Retinal fundus photograph · 2212x1659 · FOV: 45 degrees — 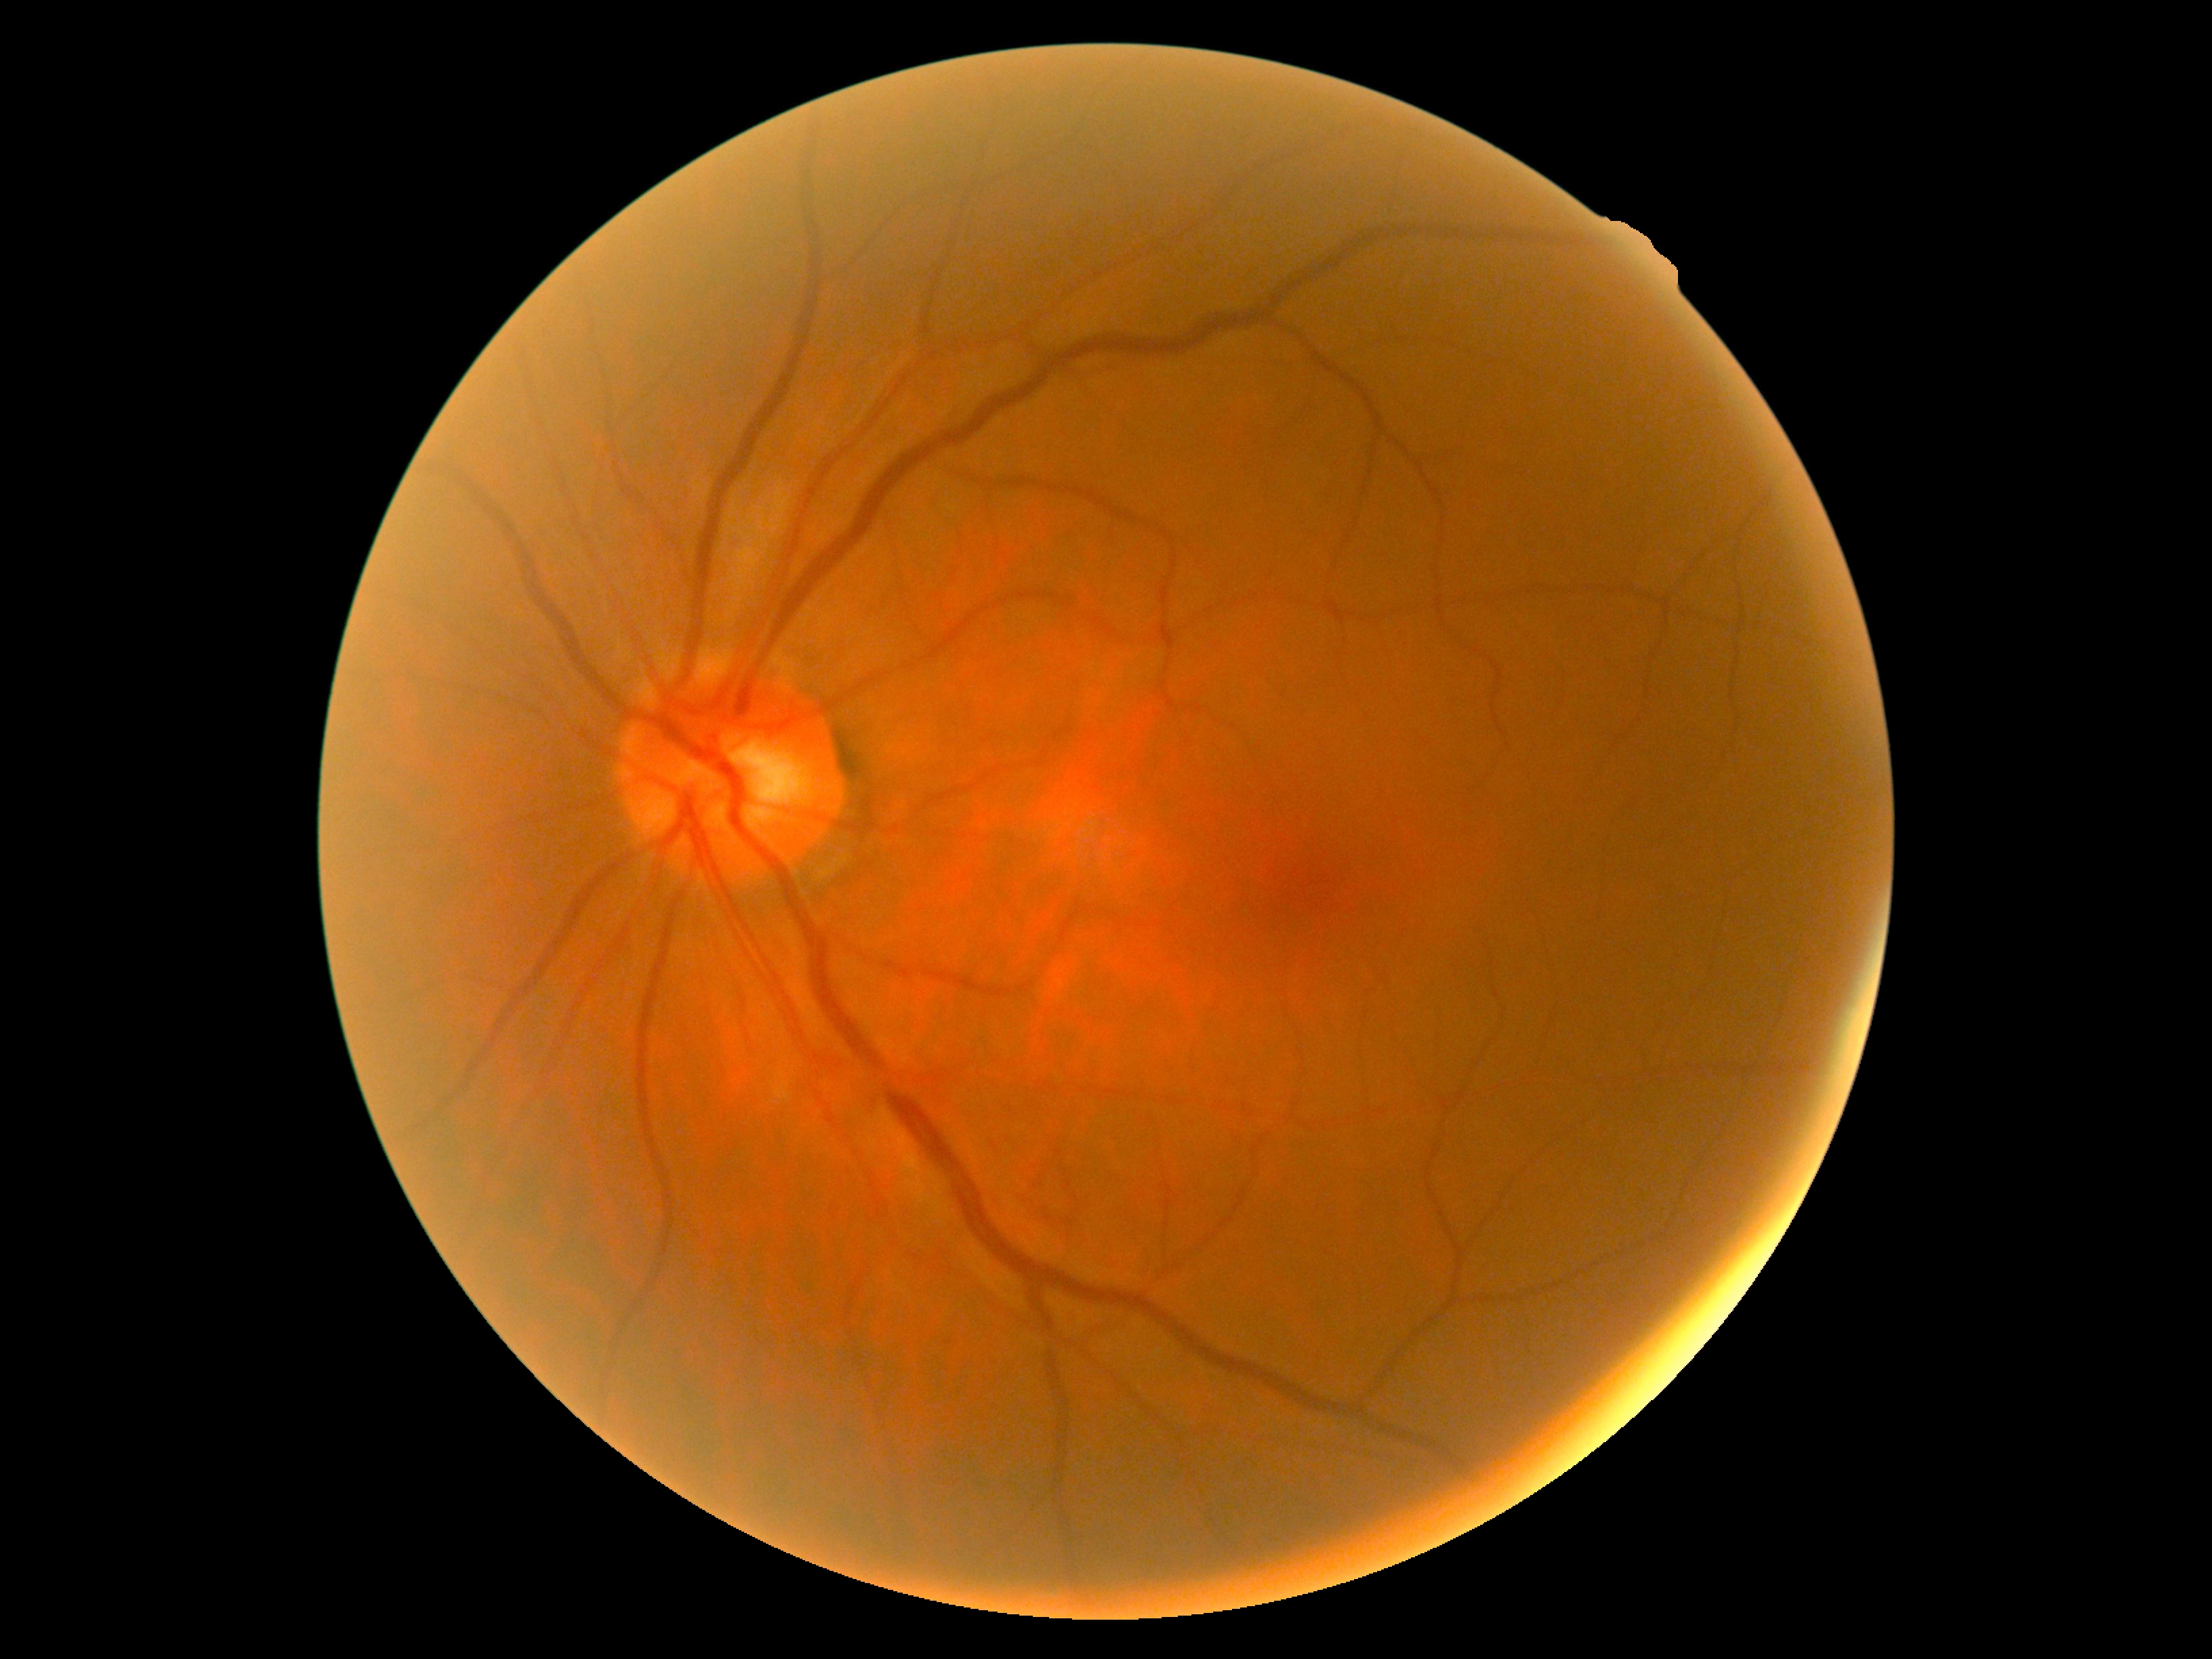 Findings:
• retinopathy — no apparent retinopathy (grade 0) — no visible signs of diabetic retinopathy